Camera: NIDEK AFC-230 · 848 x 848 pixels · 45-degree field of view
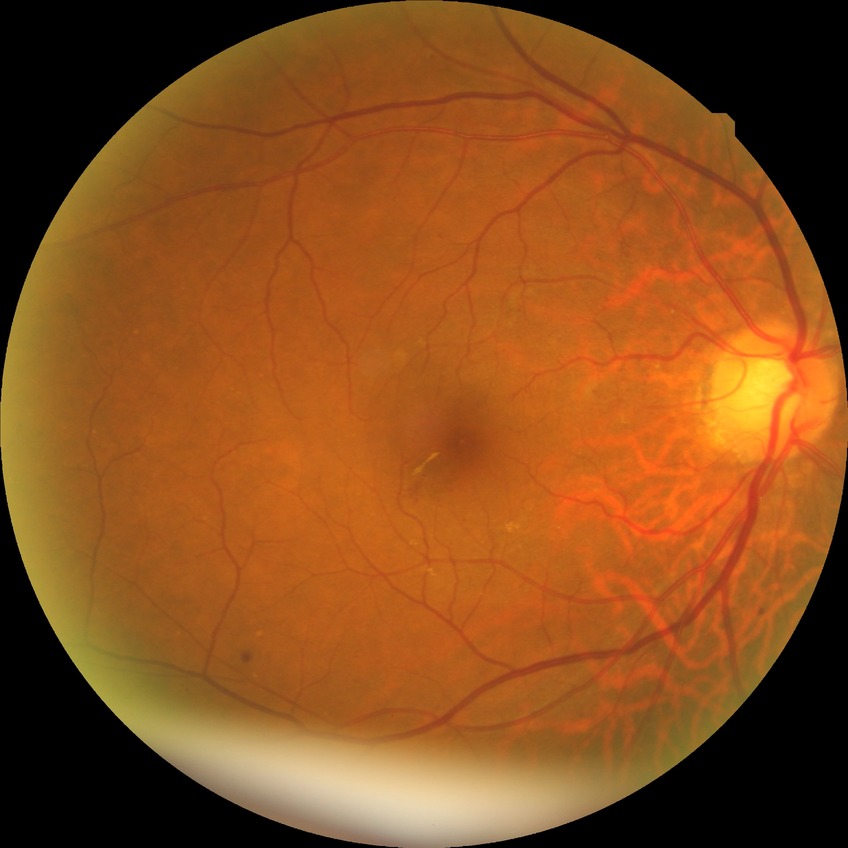

Diabetic retinopathy stage: simple diabetic retinopathy.